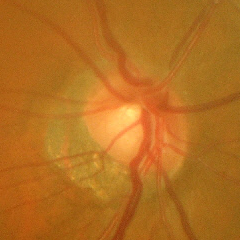

Advanced-stage glaucoma.